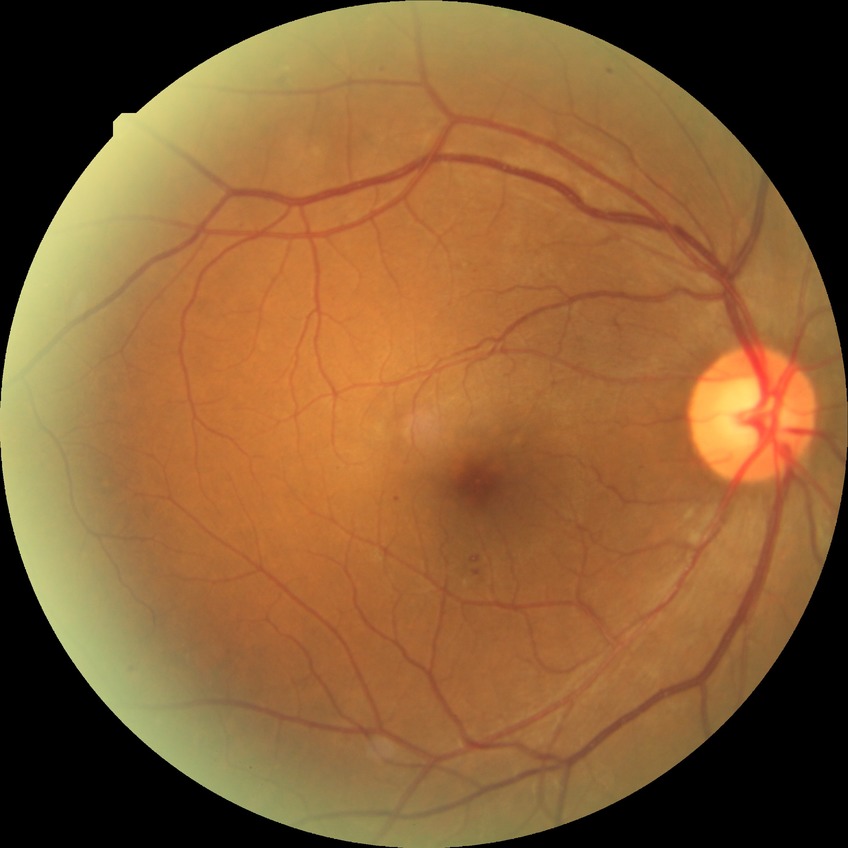 proliferative_class: non-proliferative diabetic retinopathy
davis_grade: SDR